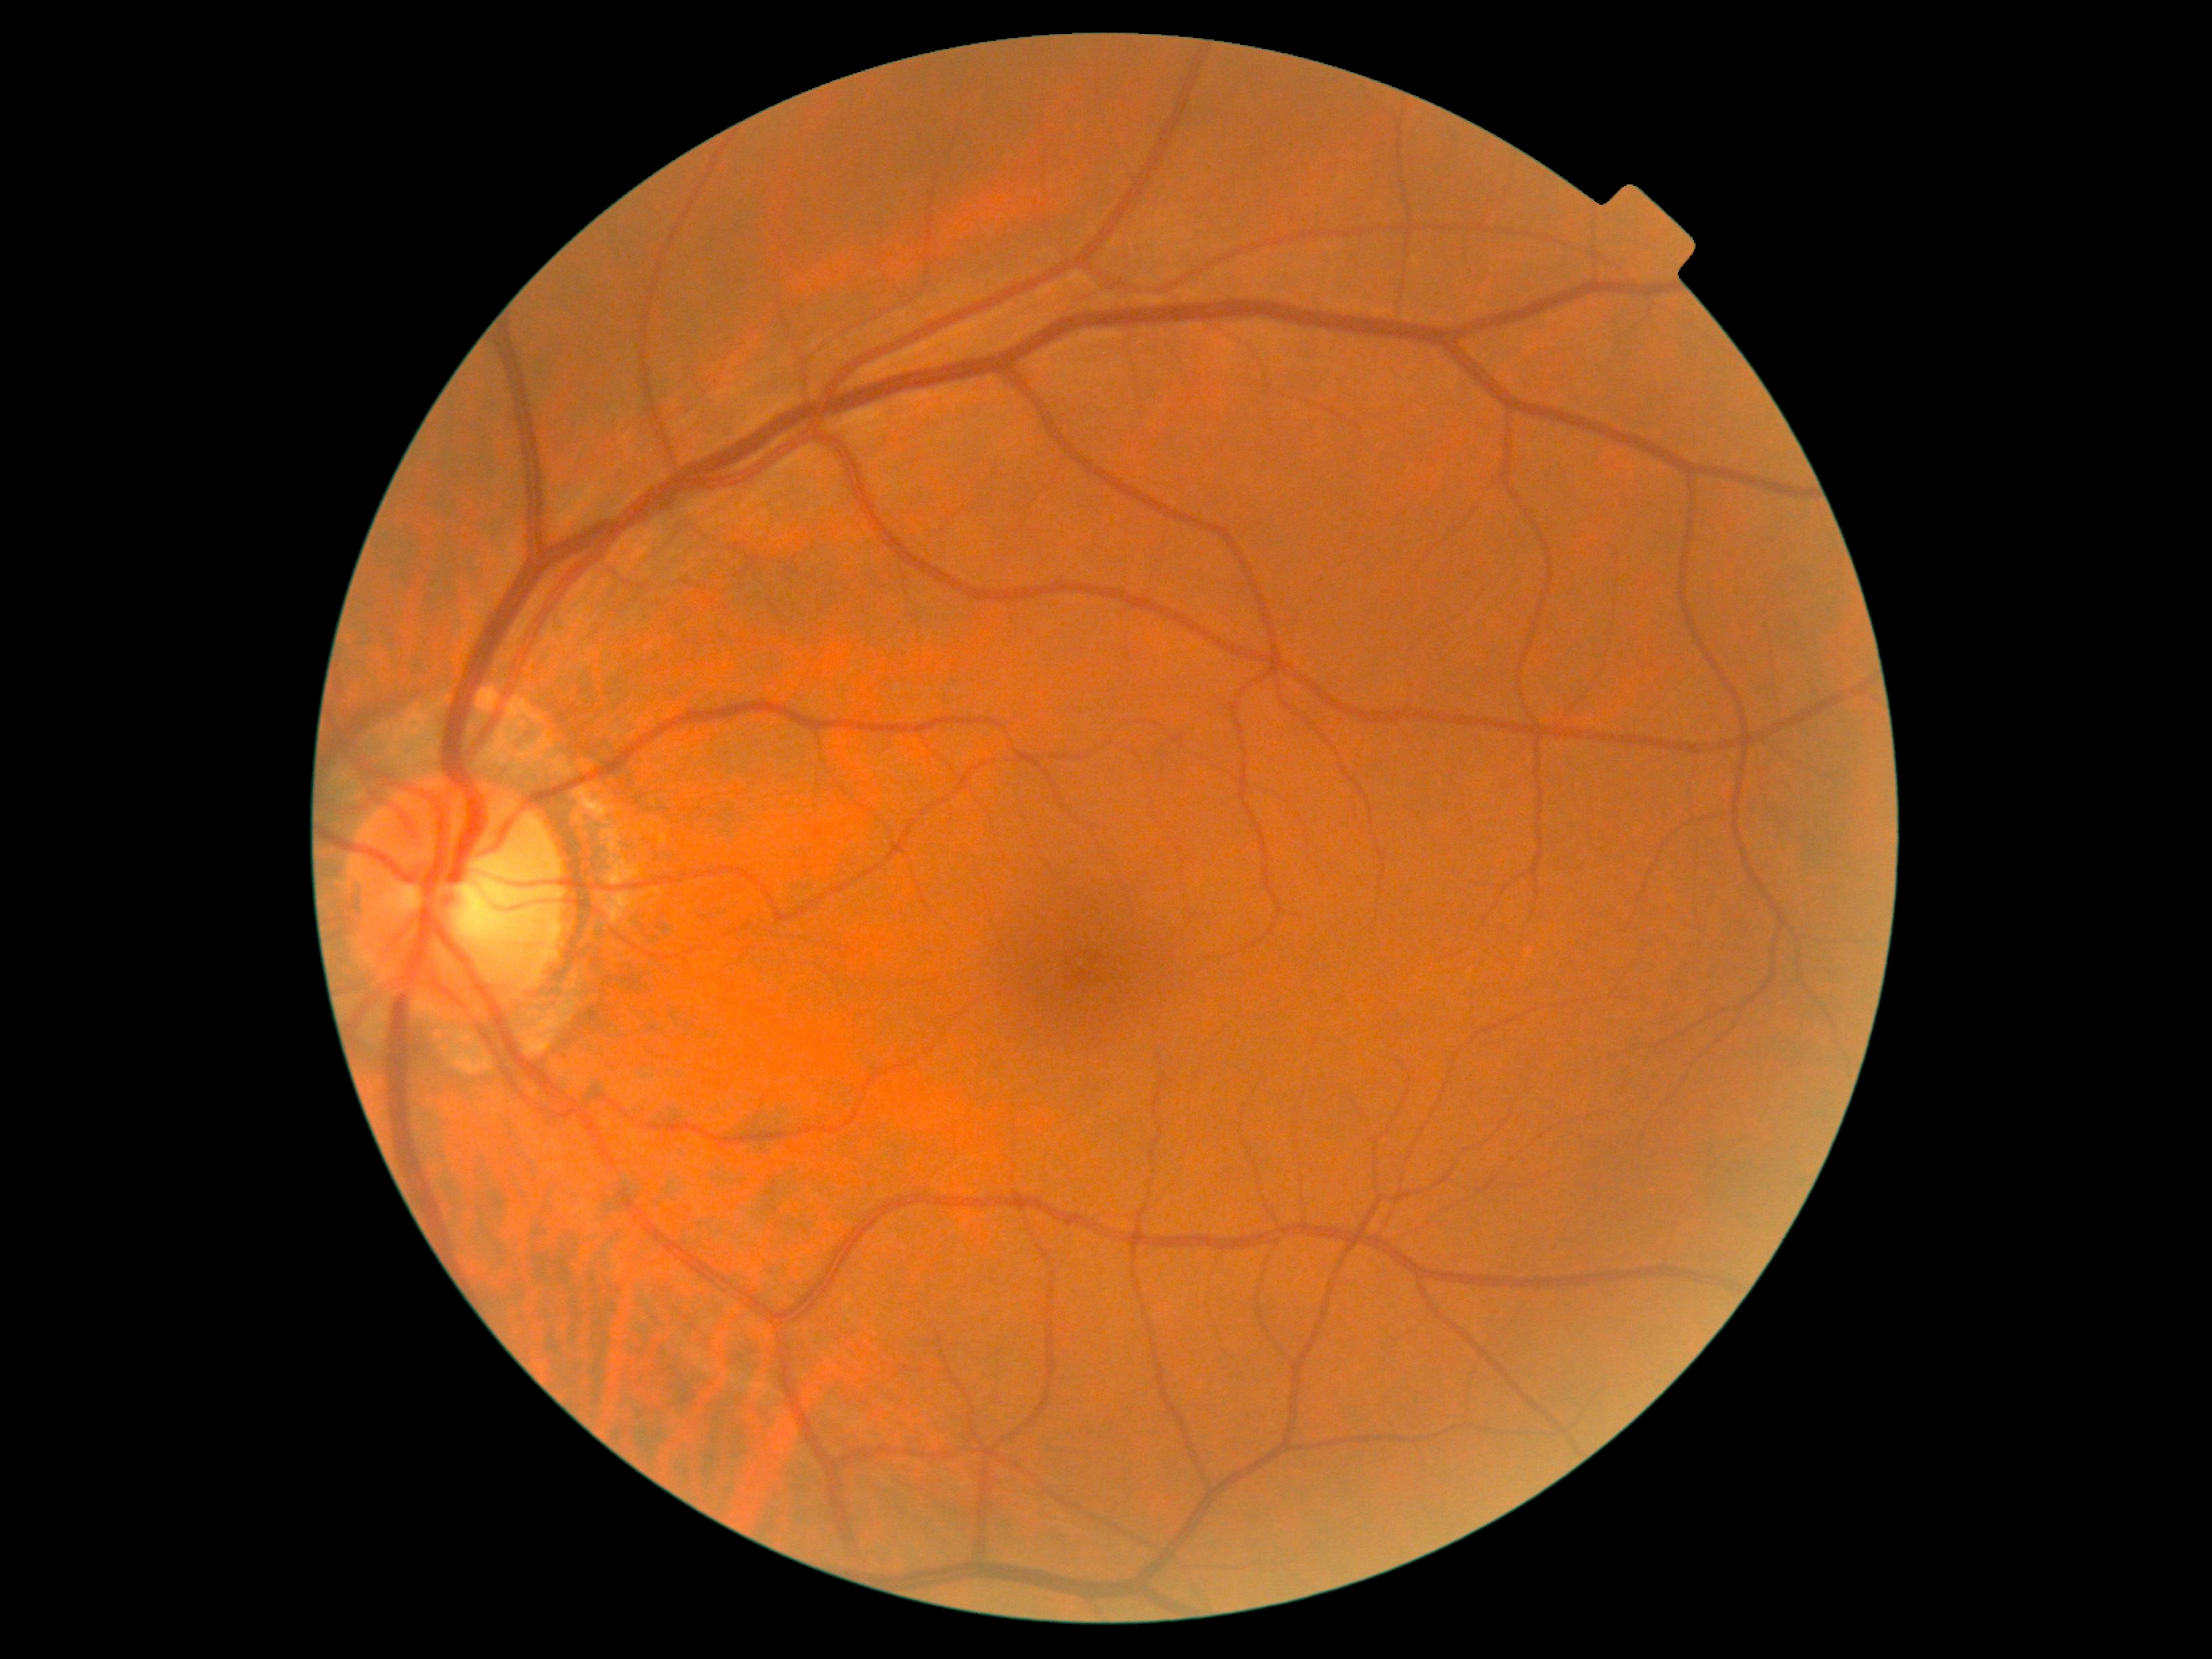

{"dr_grade": "0"}